45° field of view: 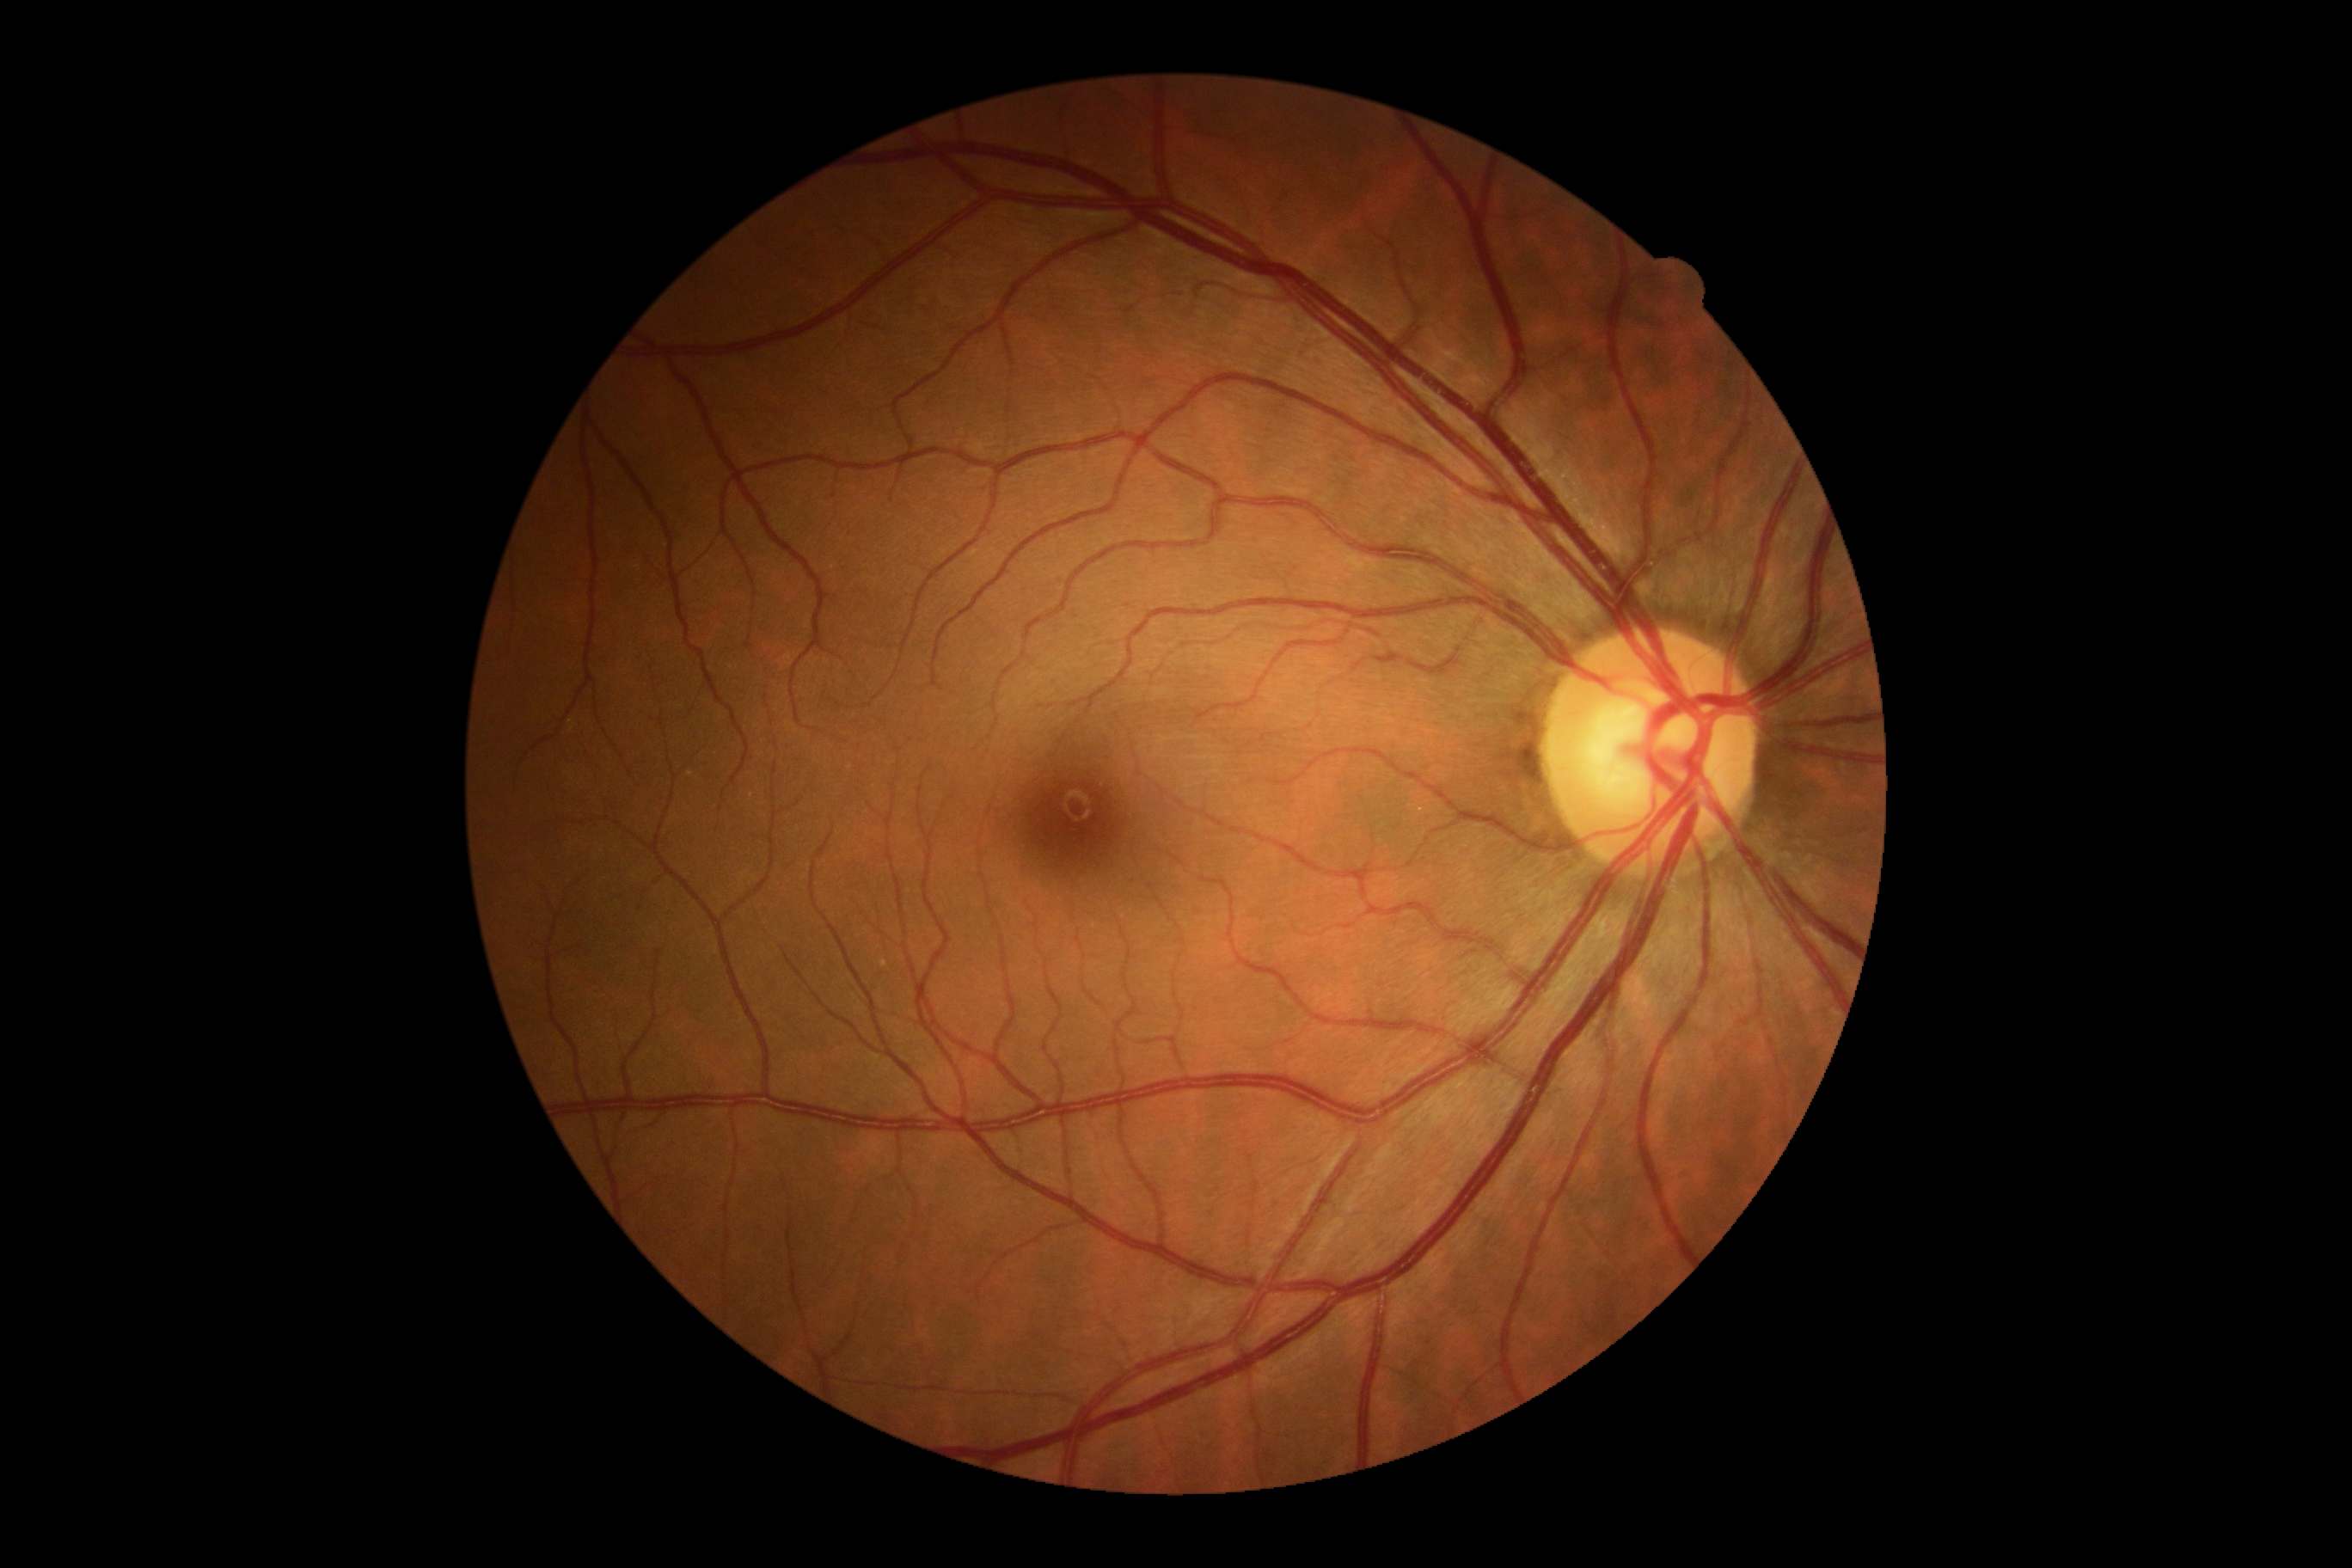

dr_grade: 0
dr_impression: no signs of DR